45° FOV: 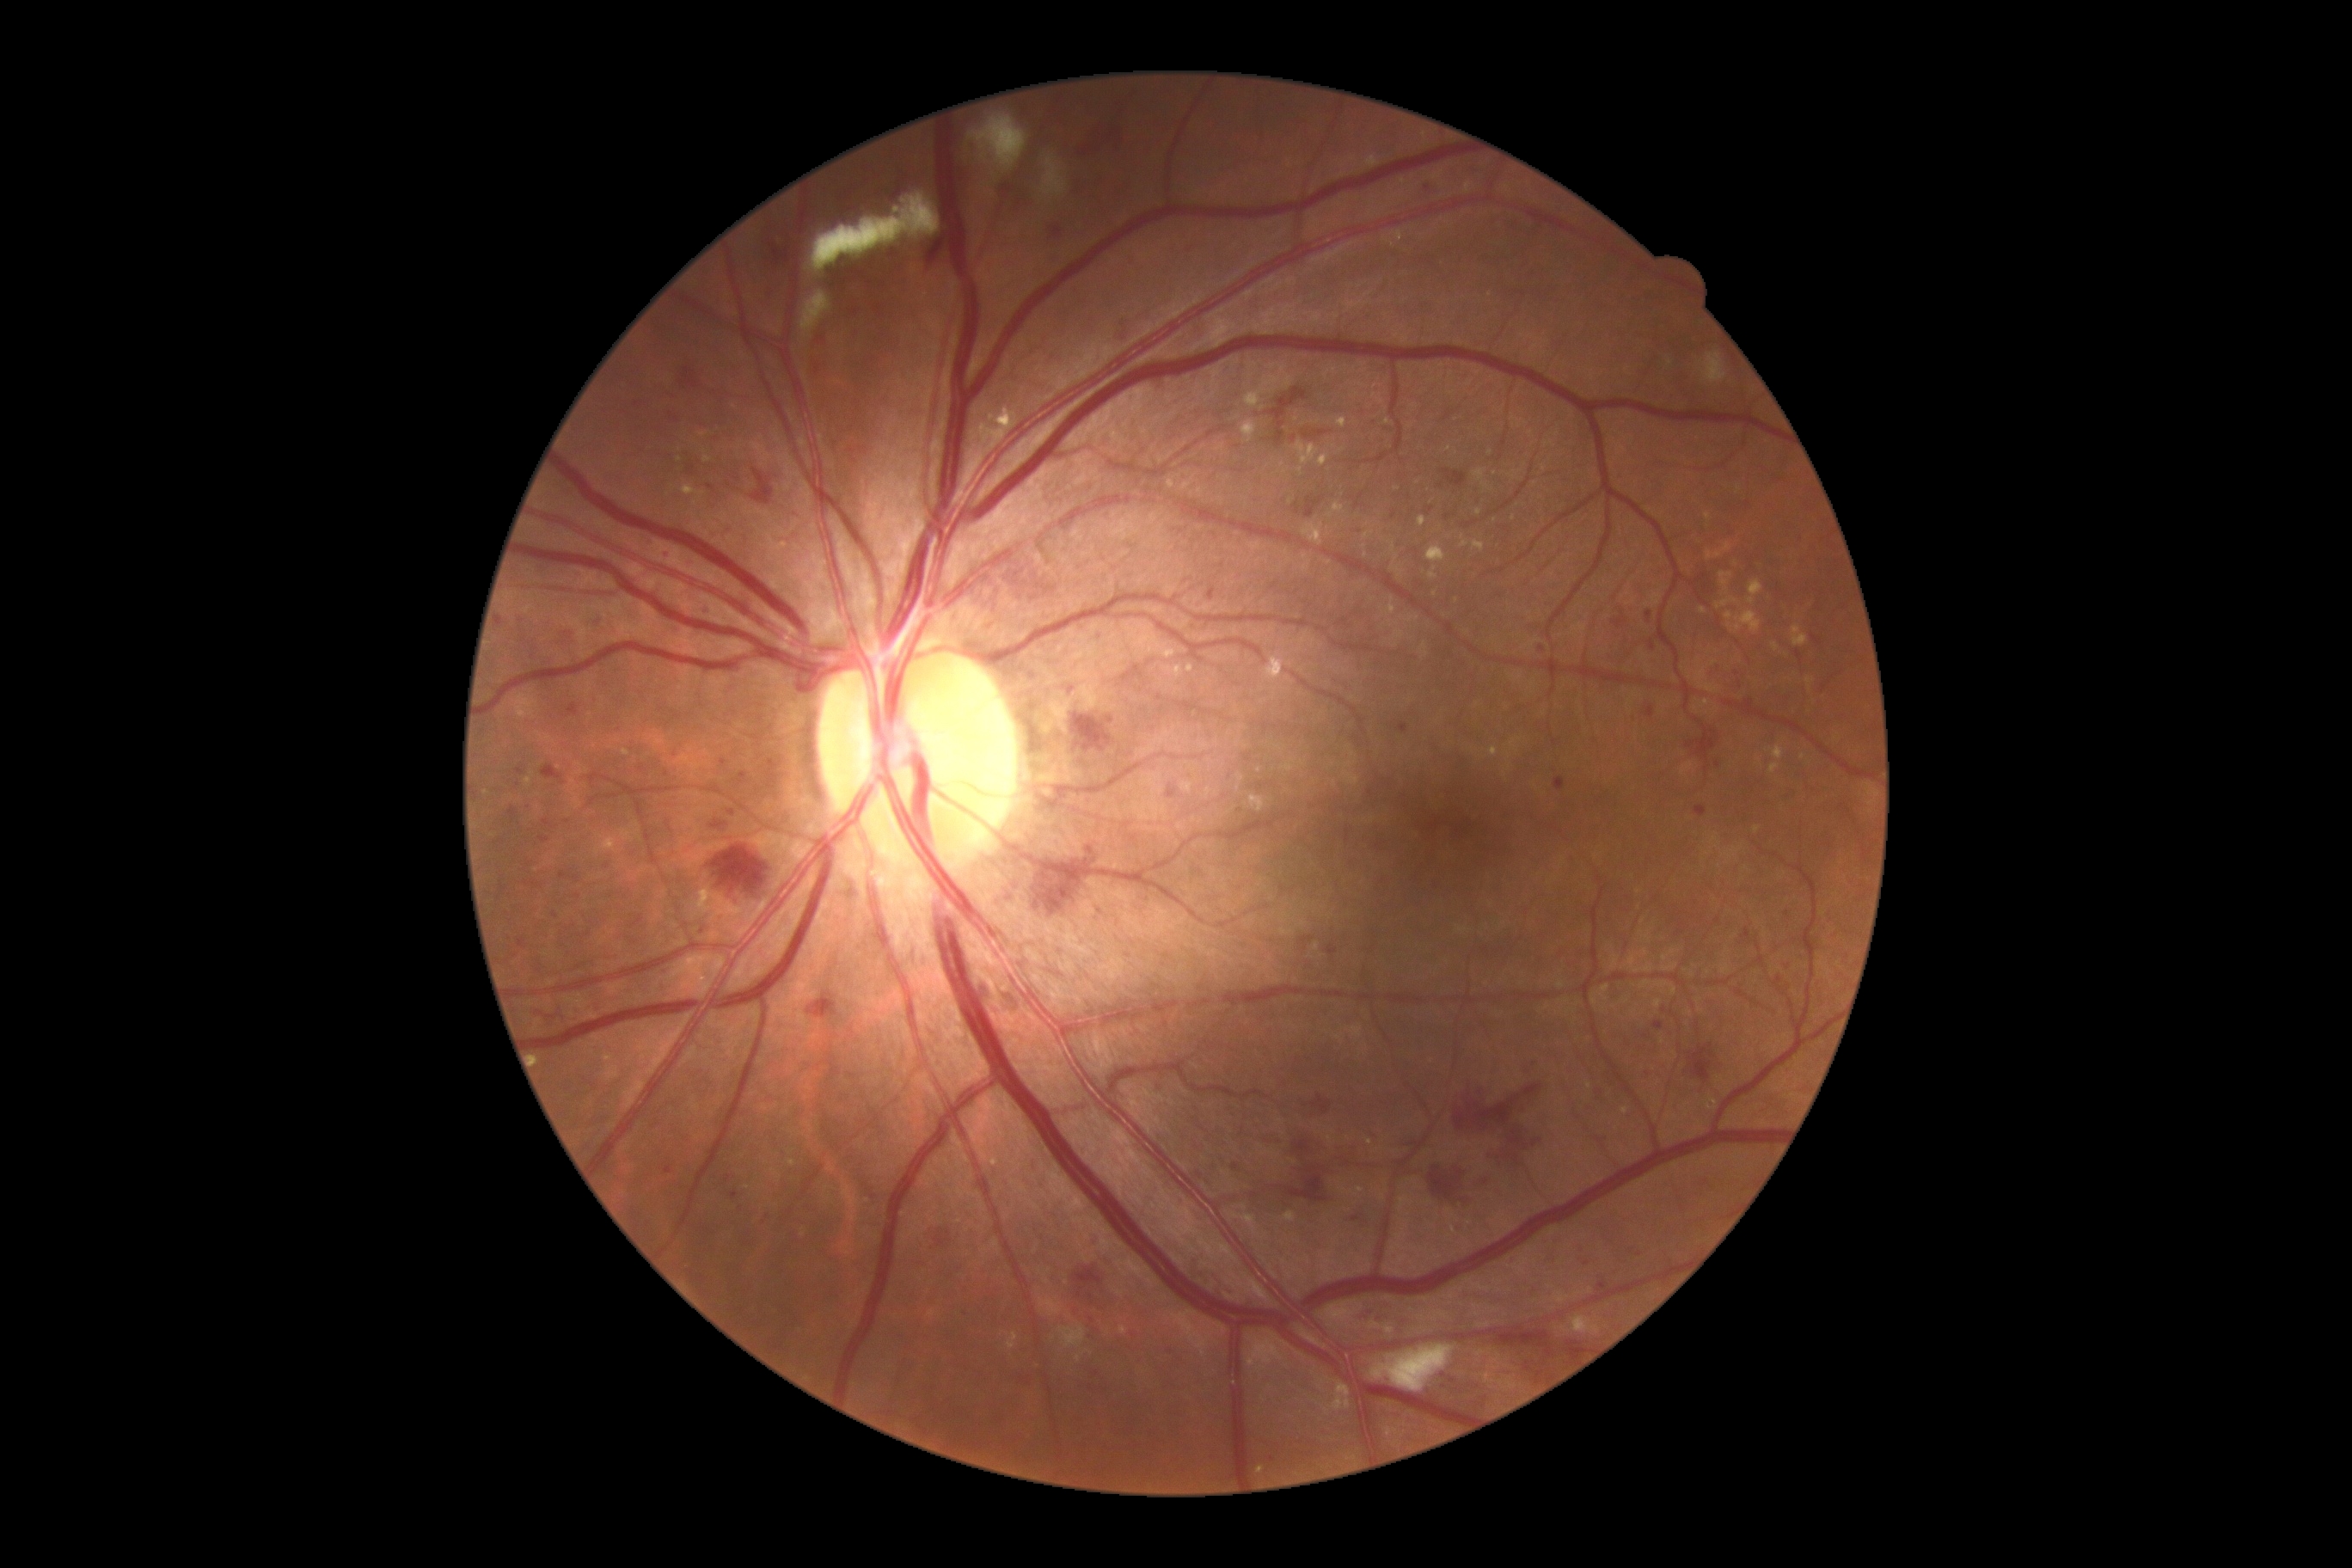
Diabetic retinopathy (DR) is 3/4 — more than 20 intraretinal hemorrhages in each of 4 quadrants, definite venous beading in 2 or more quadrants, or prominent intraretinal microvascular abnormalities in 1 or more quadrants, with no signs of proliferative retinopathy
Representative lesions:
microaneurysms (MAs) (partial) = Rect(1050, 224, 1063, 240) | Rect(1311, 1096, 1333, 1115) | Rect(1741, 929, 1751, 941) | Rect(1326, 945, 1338, 957) | Rect(1031, 671, 1039, 682) | Rect(1650, 640, 1657, 652) | Rect(683, 561, 695, 570) | Rect(517, 769, 525, 776) | Rect(964, 1311, 971, 1320) | Rect(1526, 1069, 1533, 1077) | Rect(1424, 508, 1433, 517)
Smaller MAs around 1361, 1166 | 577, 897 | 1375, 423 | 1830, 846 | 635, 943 | 637, 405 | 1390, 427 | 1717, 765 | 731, 813
hard exudates (EXs) (partial) = Rect(1364, 156, 1380, 169) | Rect(1473, 541, 1485, 553) | Rect(1572, 1316, 1600, 1335) | Rect(623, 1077, 646, 1112) | Rect(1363, 532, 1373, 541) | Rect(1792, 625, 1808, 647) | Rect(1772, 644, 1780, 652) | Rect(1474, 469, 1488, 489) | Rect(1755, 826, 1760, 835) | Rect(1206, 788, 1213, 797) | Rect(1770, 763, 1780, 775)
Smaller EXs around 1334, 448 | 626, 752 | 1662, 1041 | 1735, 565 | 747, 1188 | 1544, 468 | 680, 460